848 x 848 pixels, NIDEK AFC-230 fundus camera, nonmydriatic fundus photograph, retinal fundus photograph
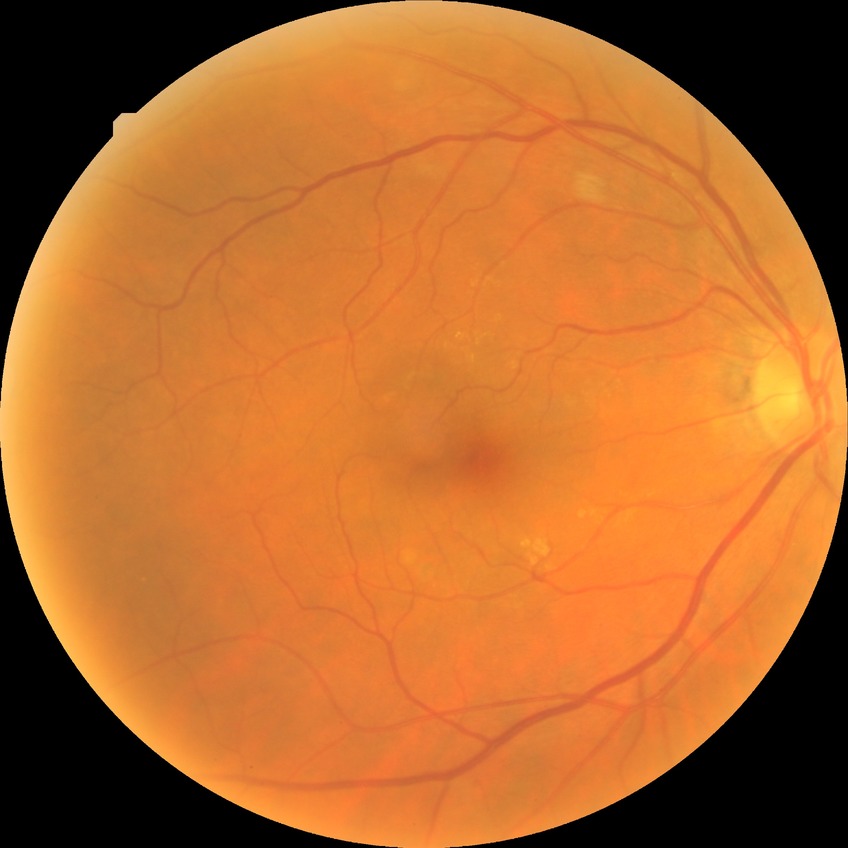

Diabetic retinopathy (DR): NDR (no diabetic retinopathy).